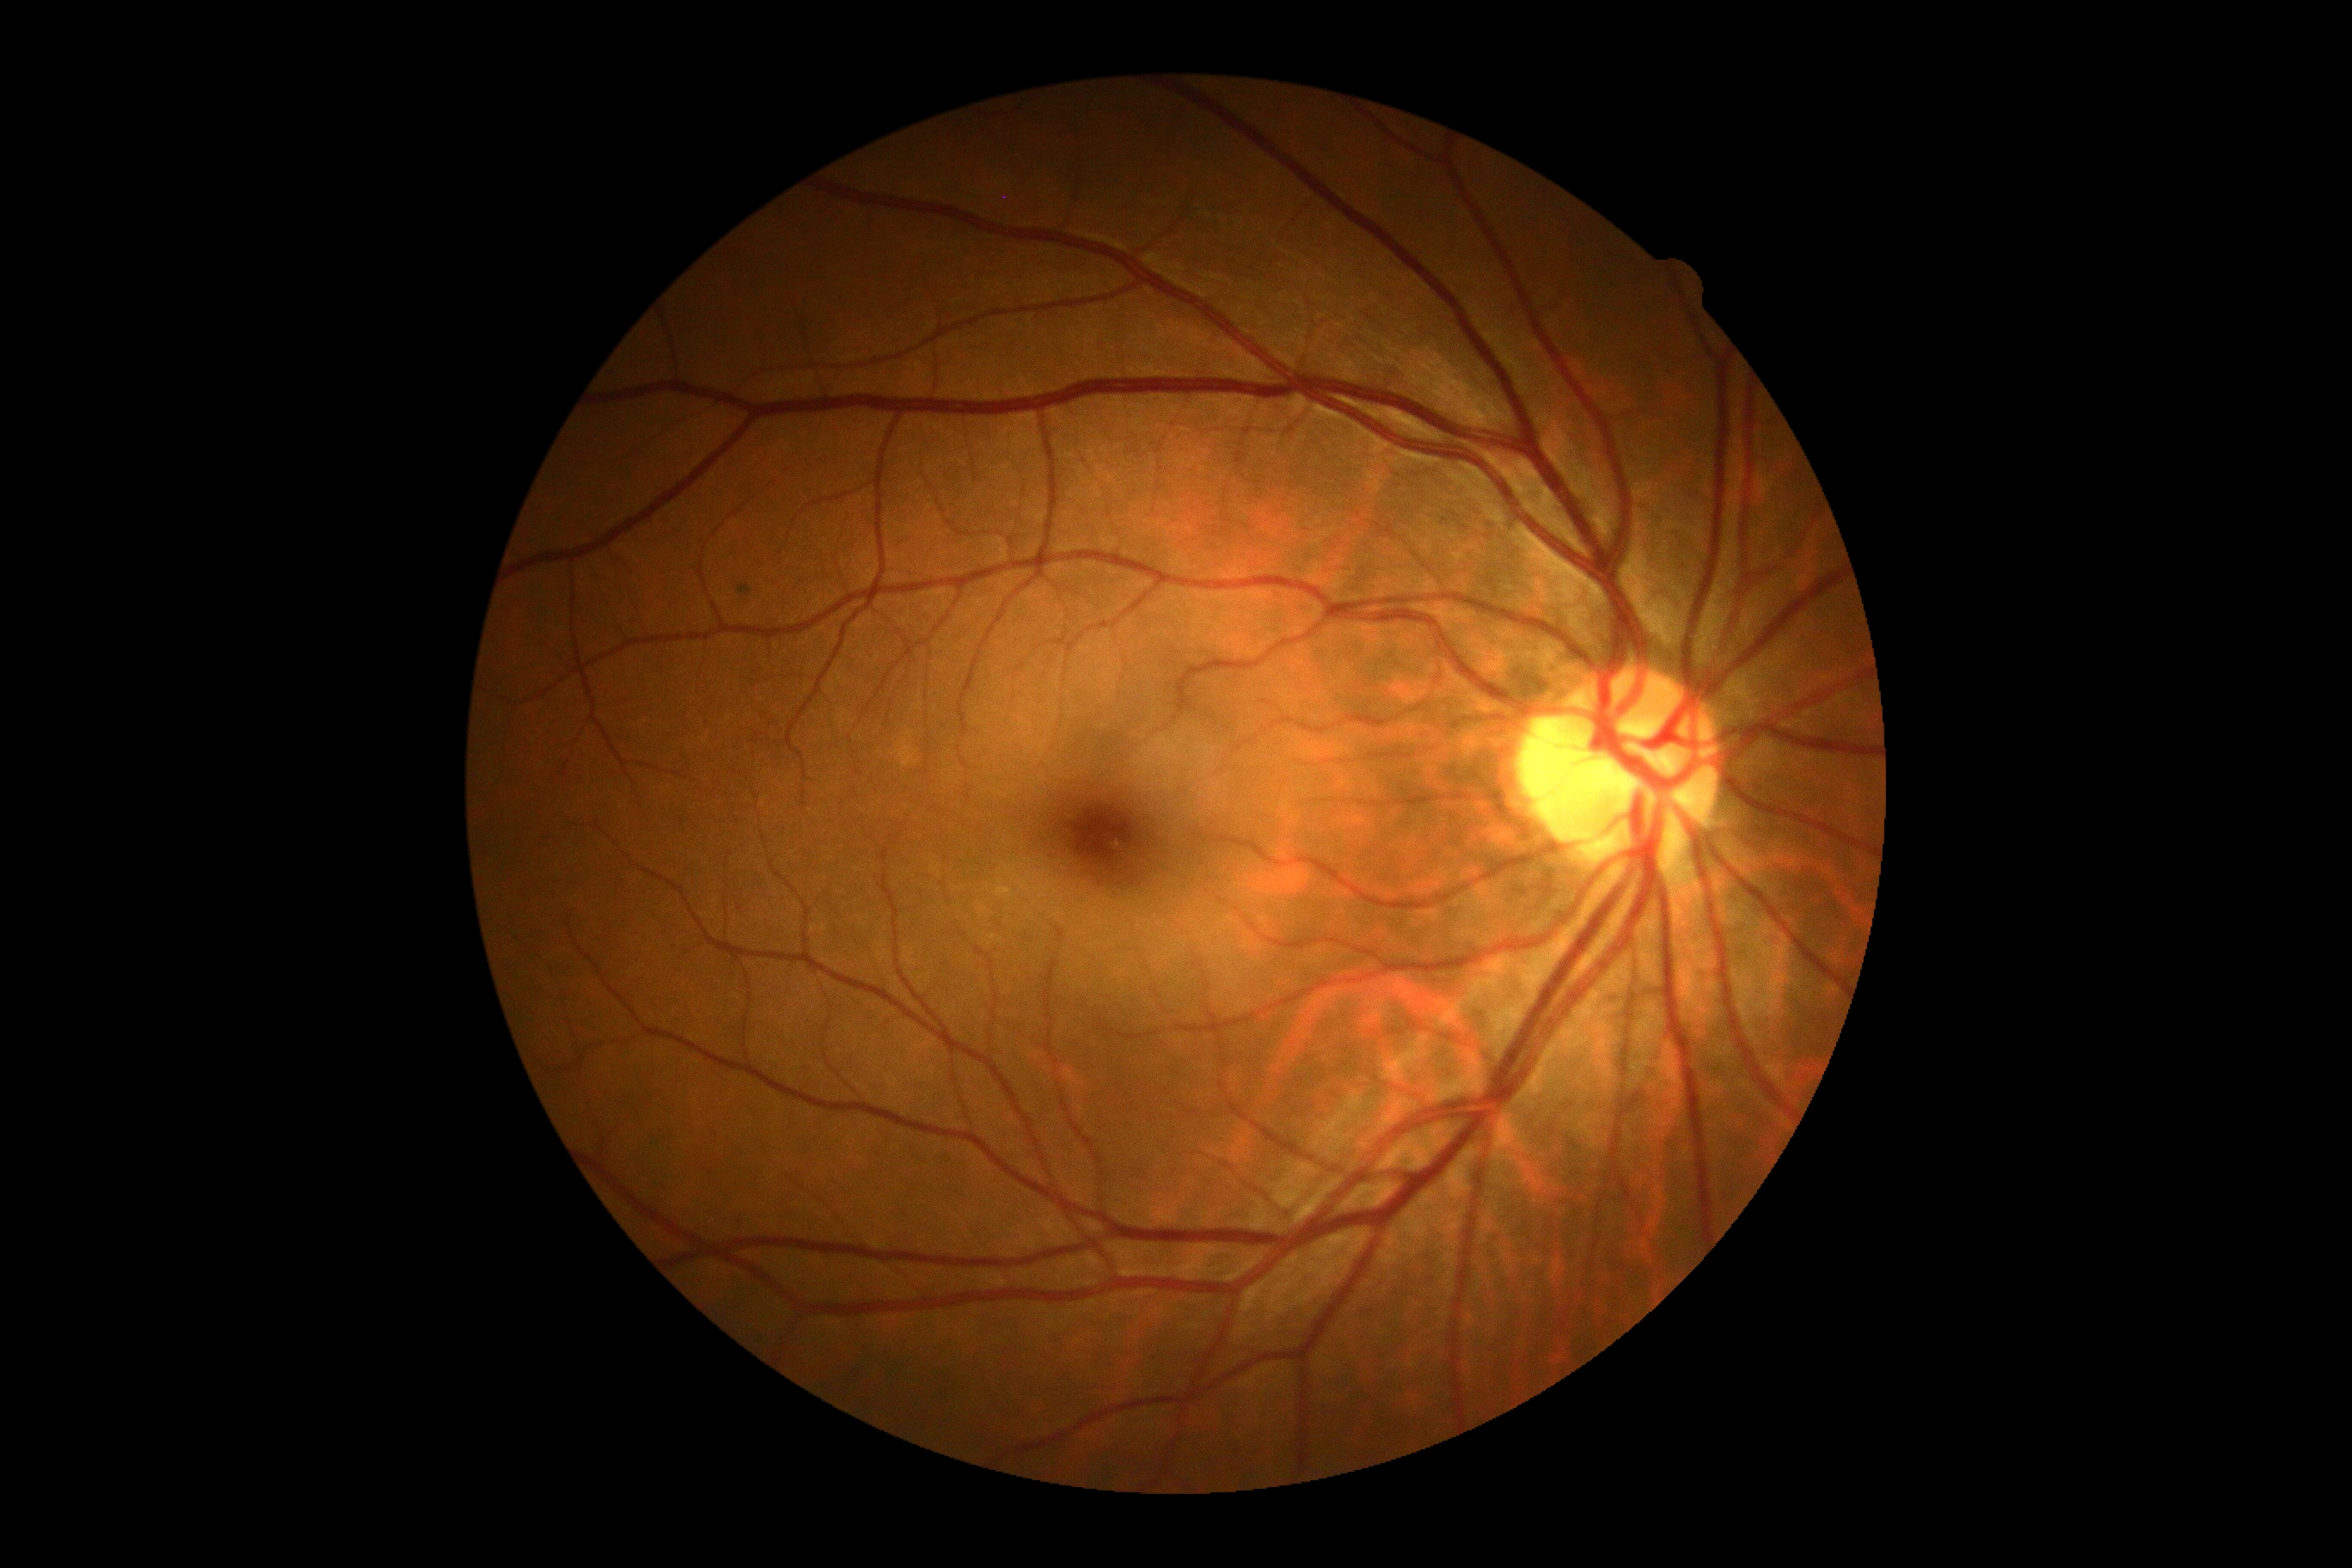 DR is grade 0 (no apparent retinopathy).